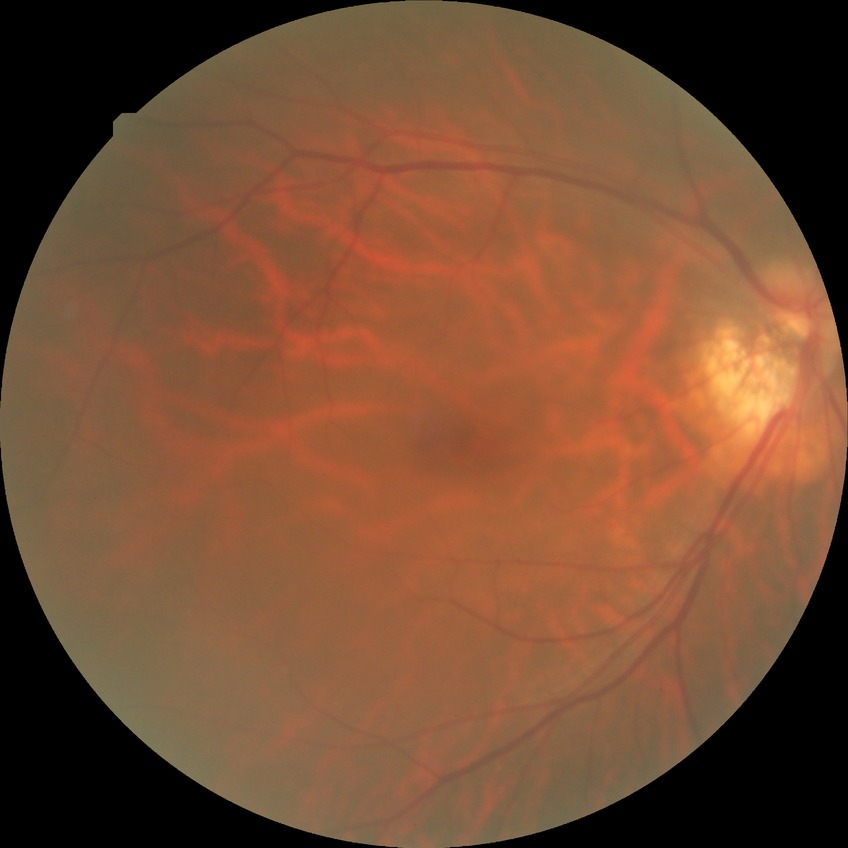
Diabetic retinopathy (DR): NDR (no diabetic retinopathy).